45-degree field of view: 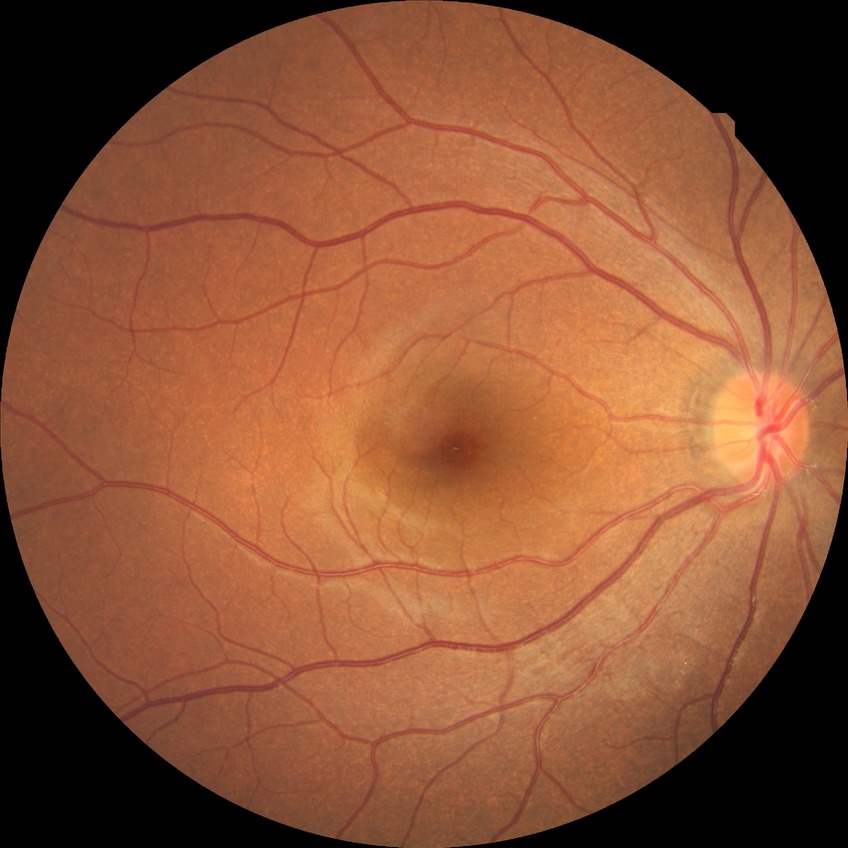 diabetic retinopathy grade: no diabetic retinopathy.